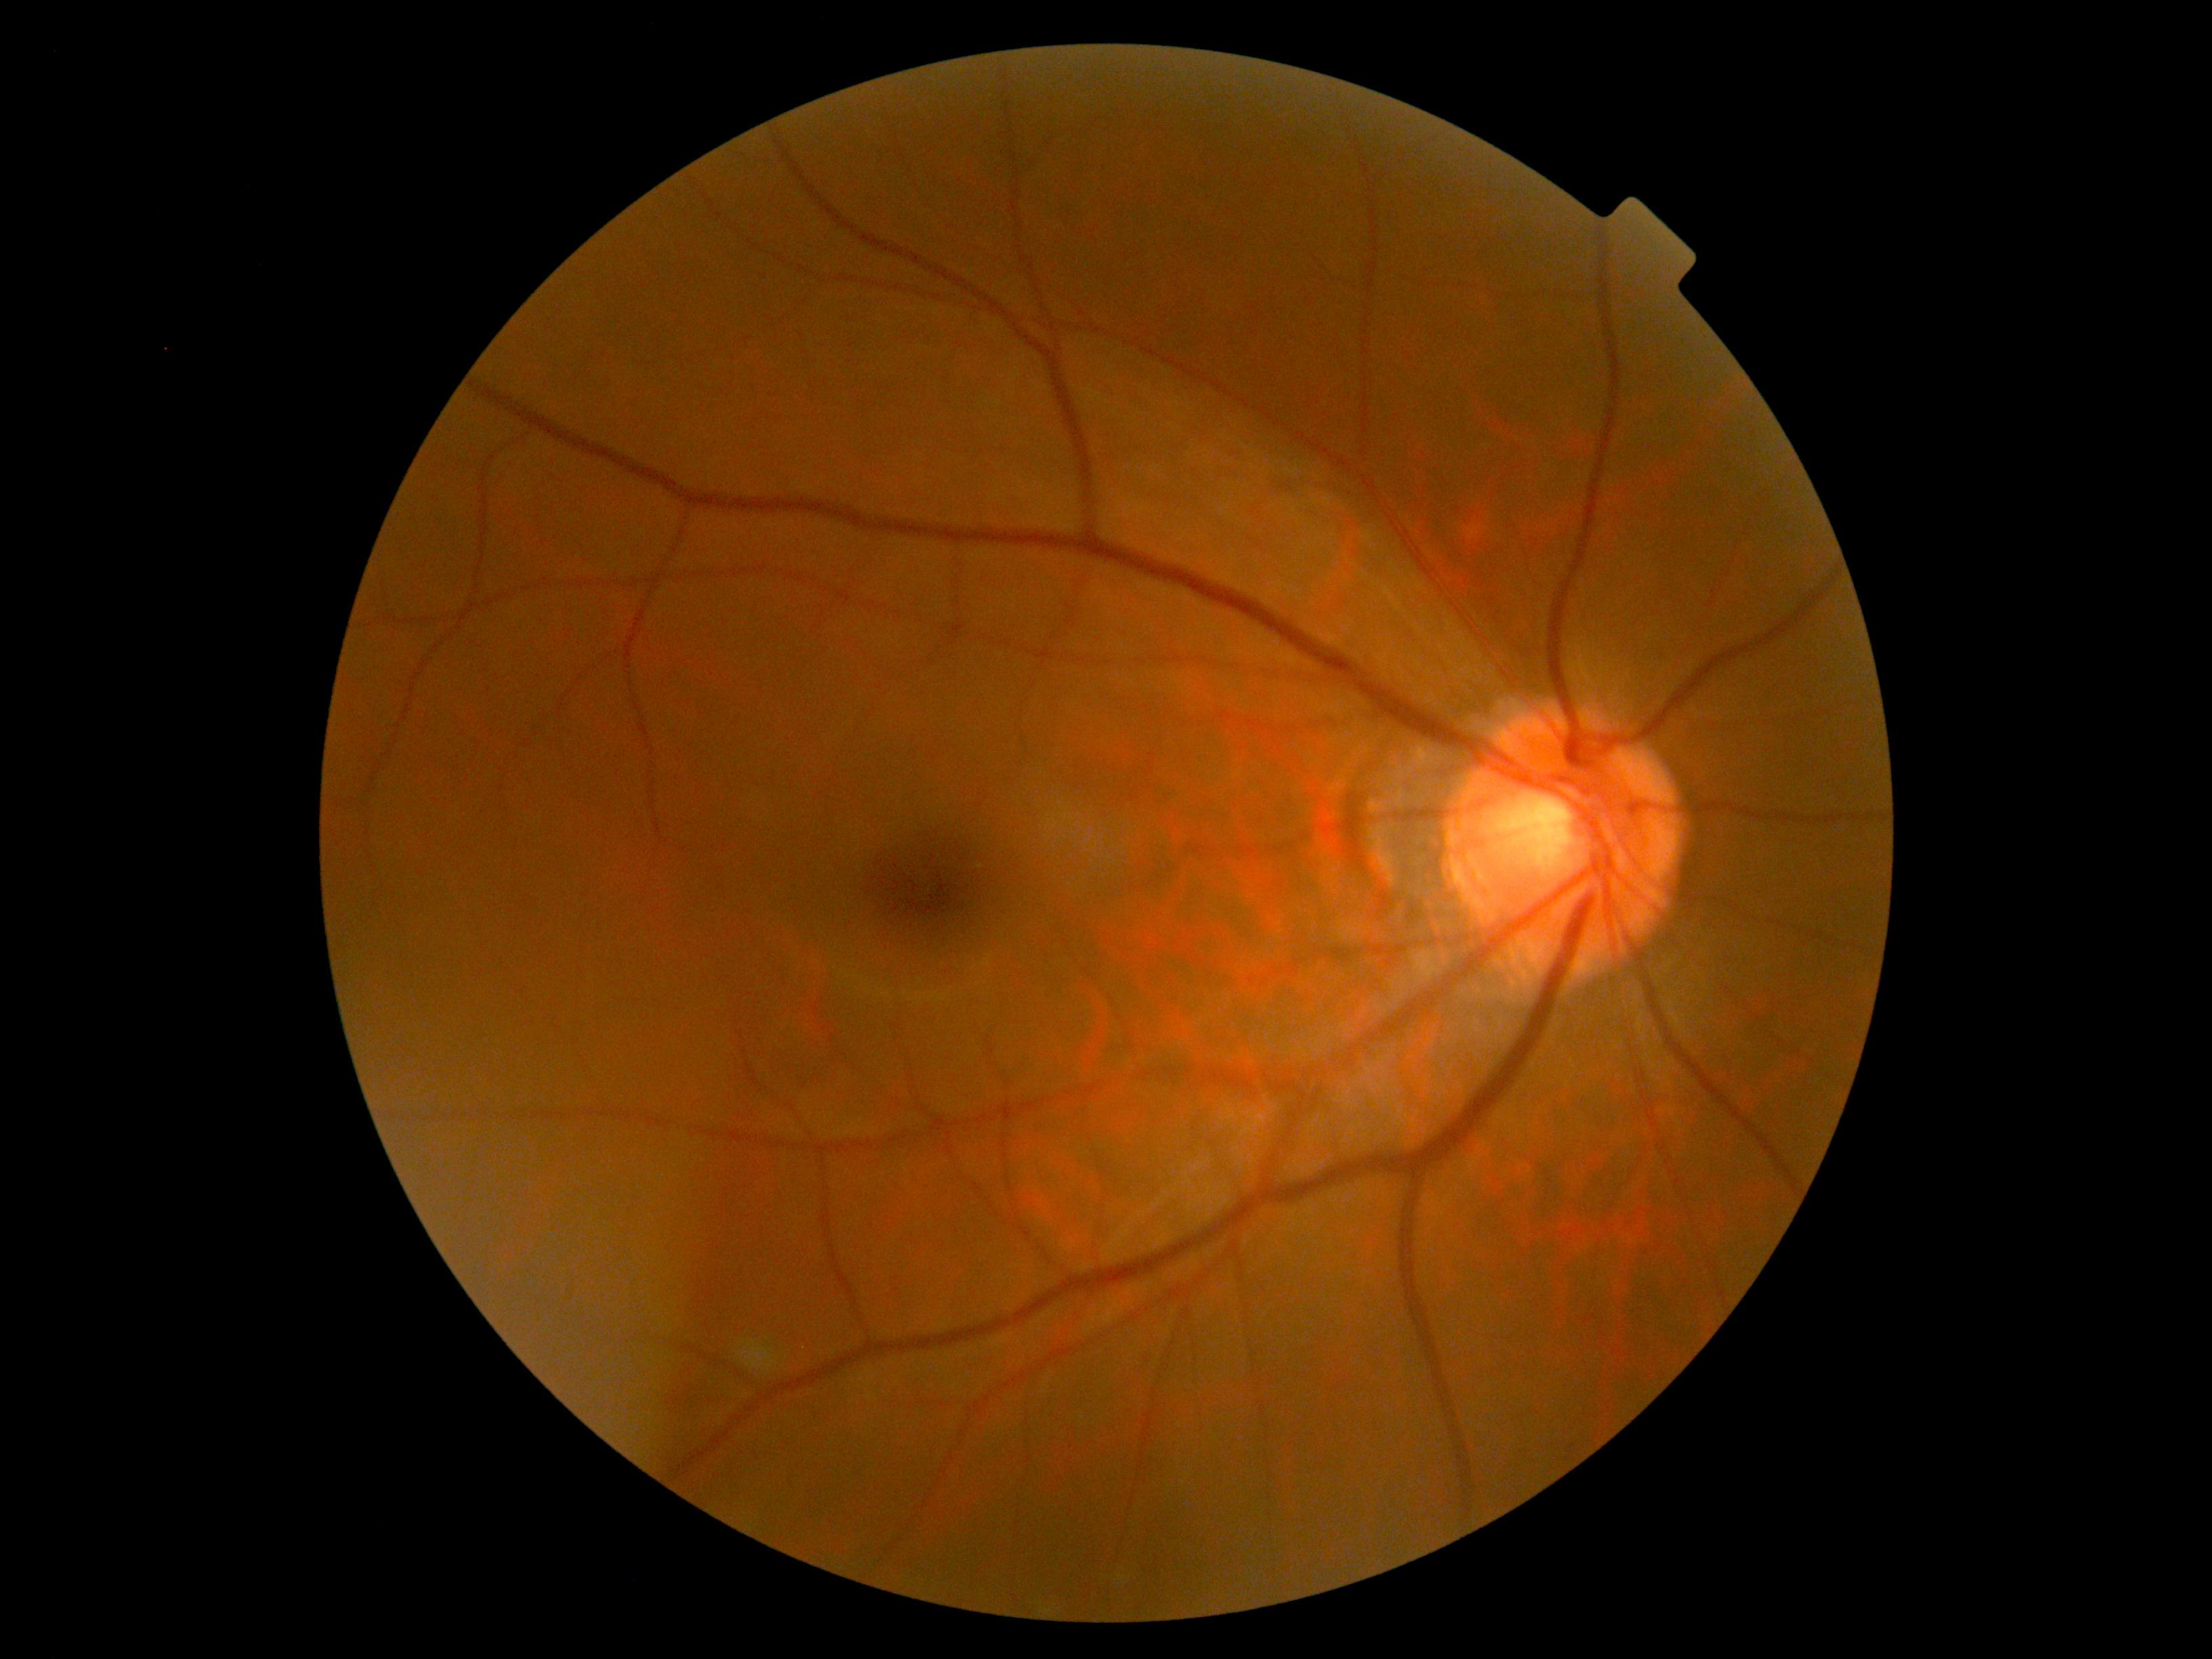
retinopathy grade = 0.